Image size 2346x1568
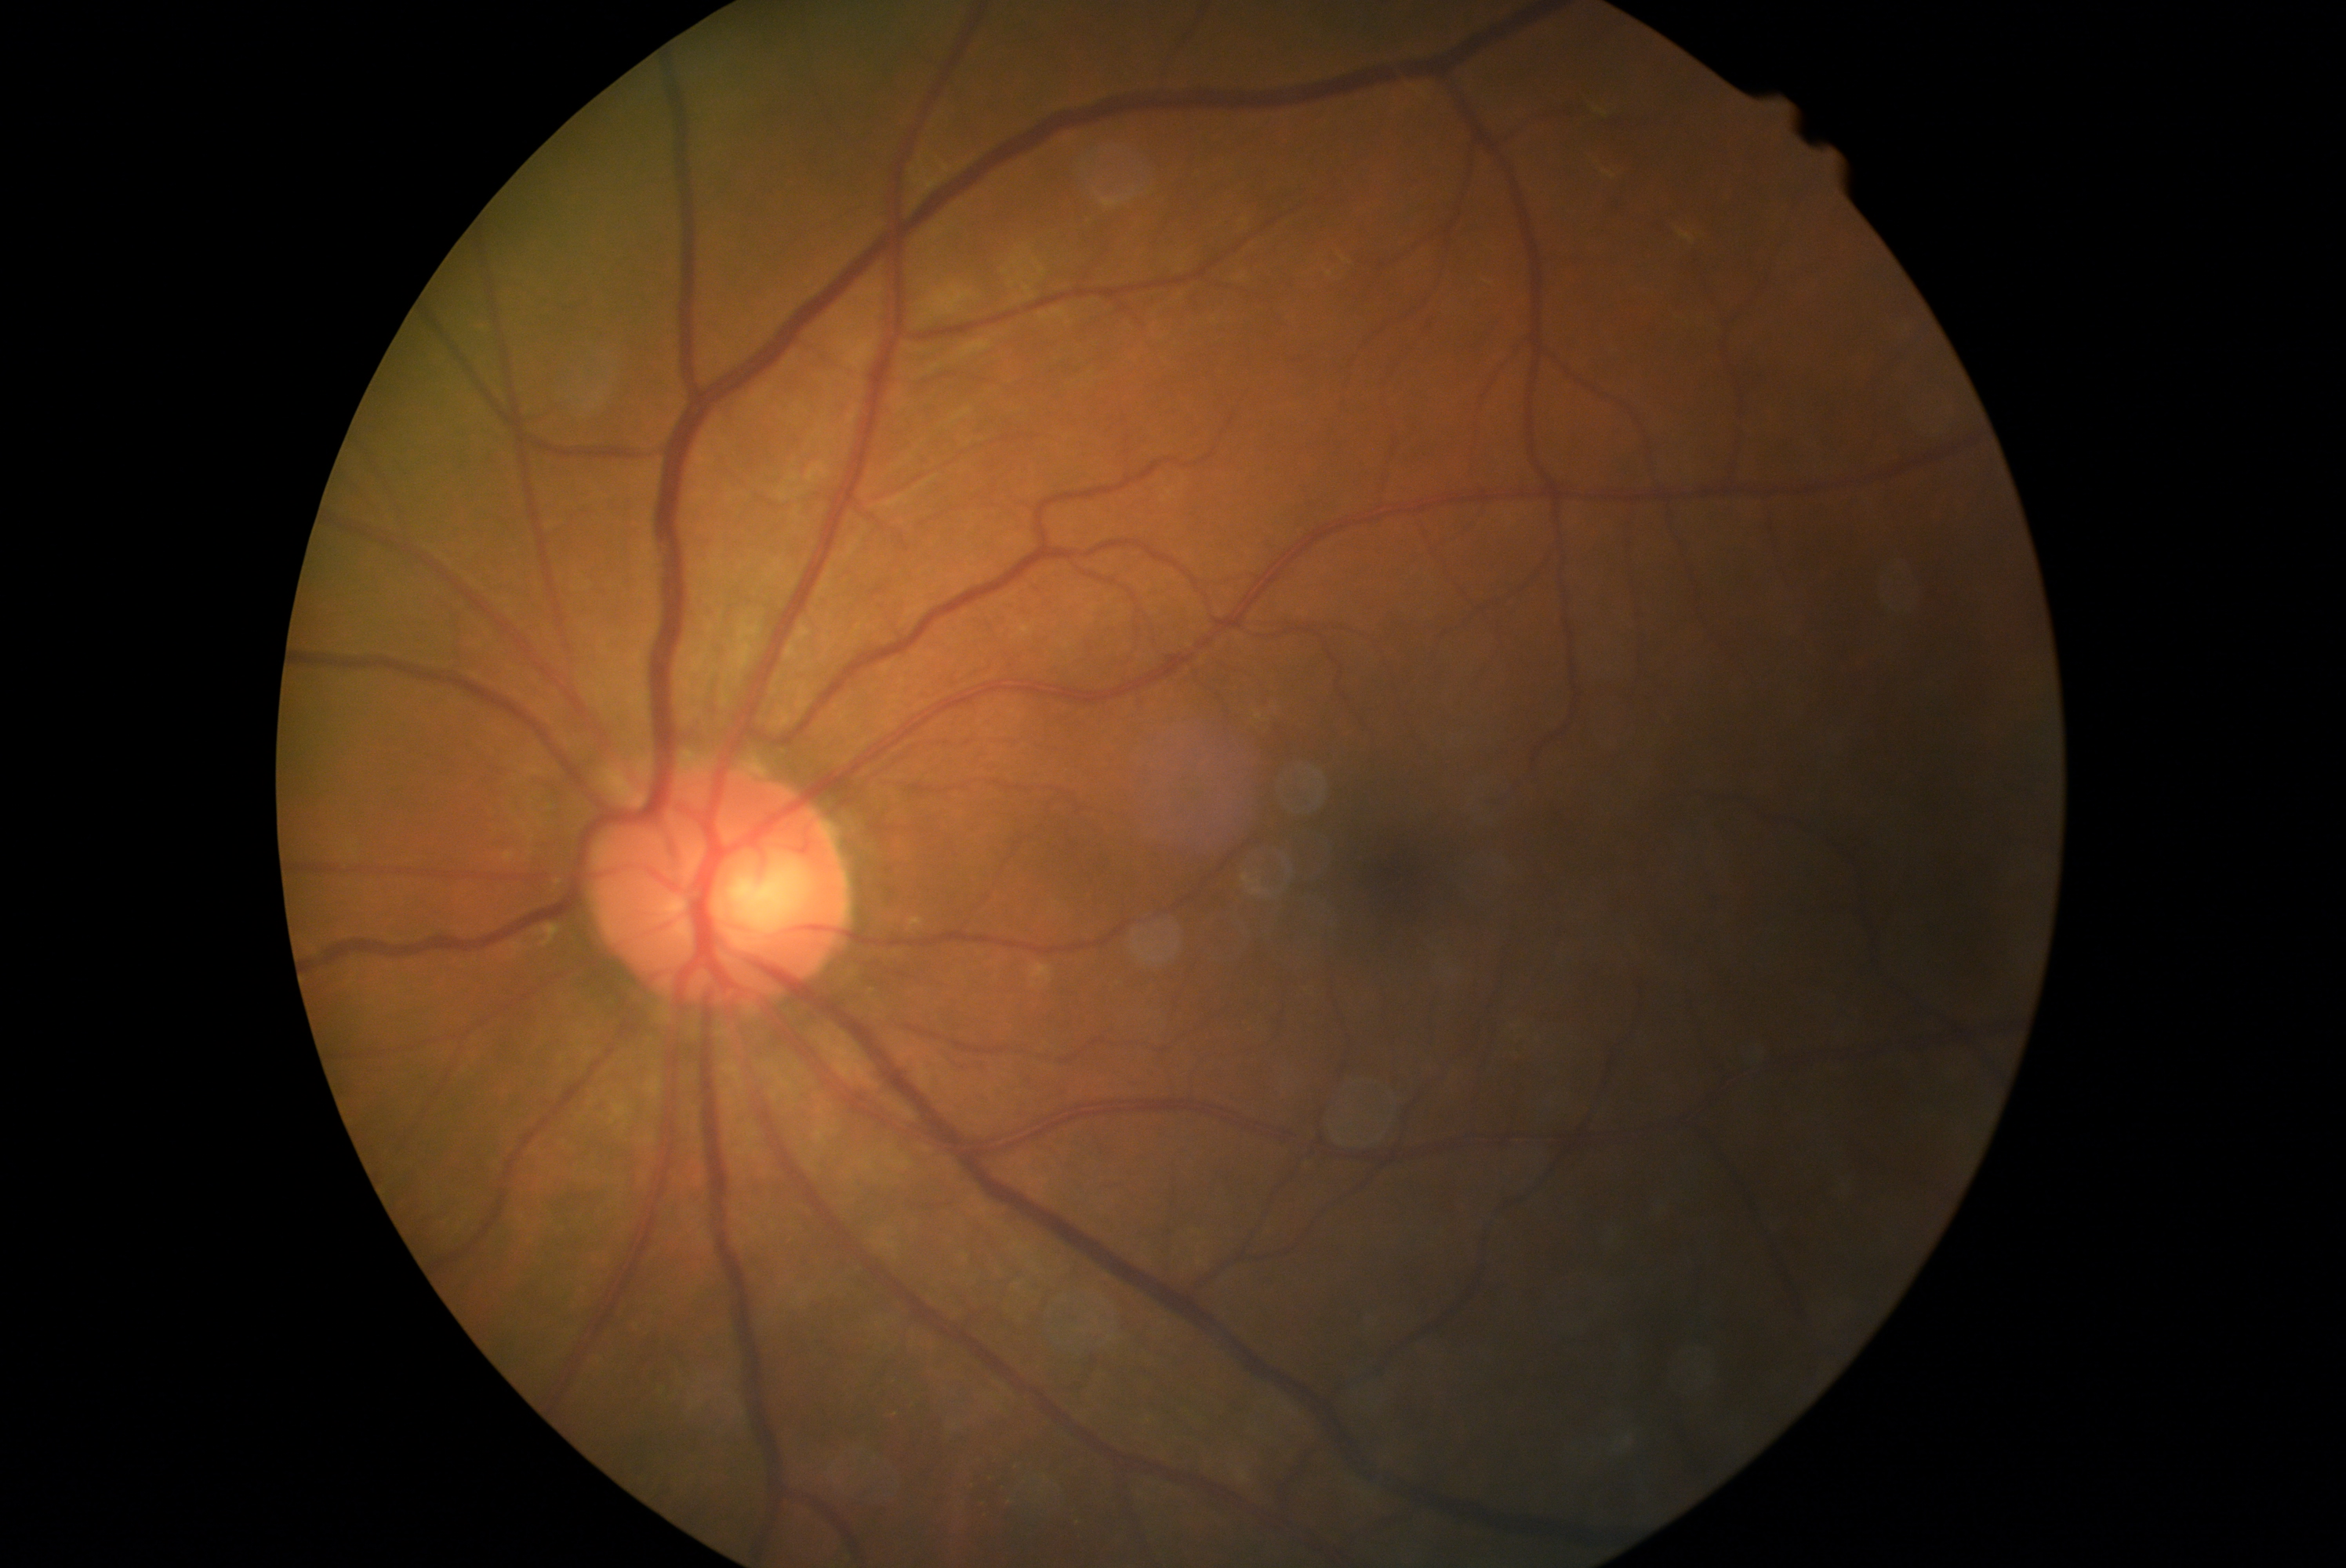
DR severity is no apparent diabetic retinopathy (grade 0).